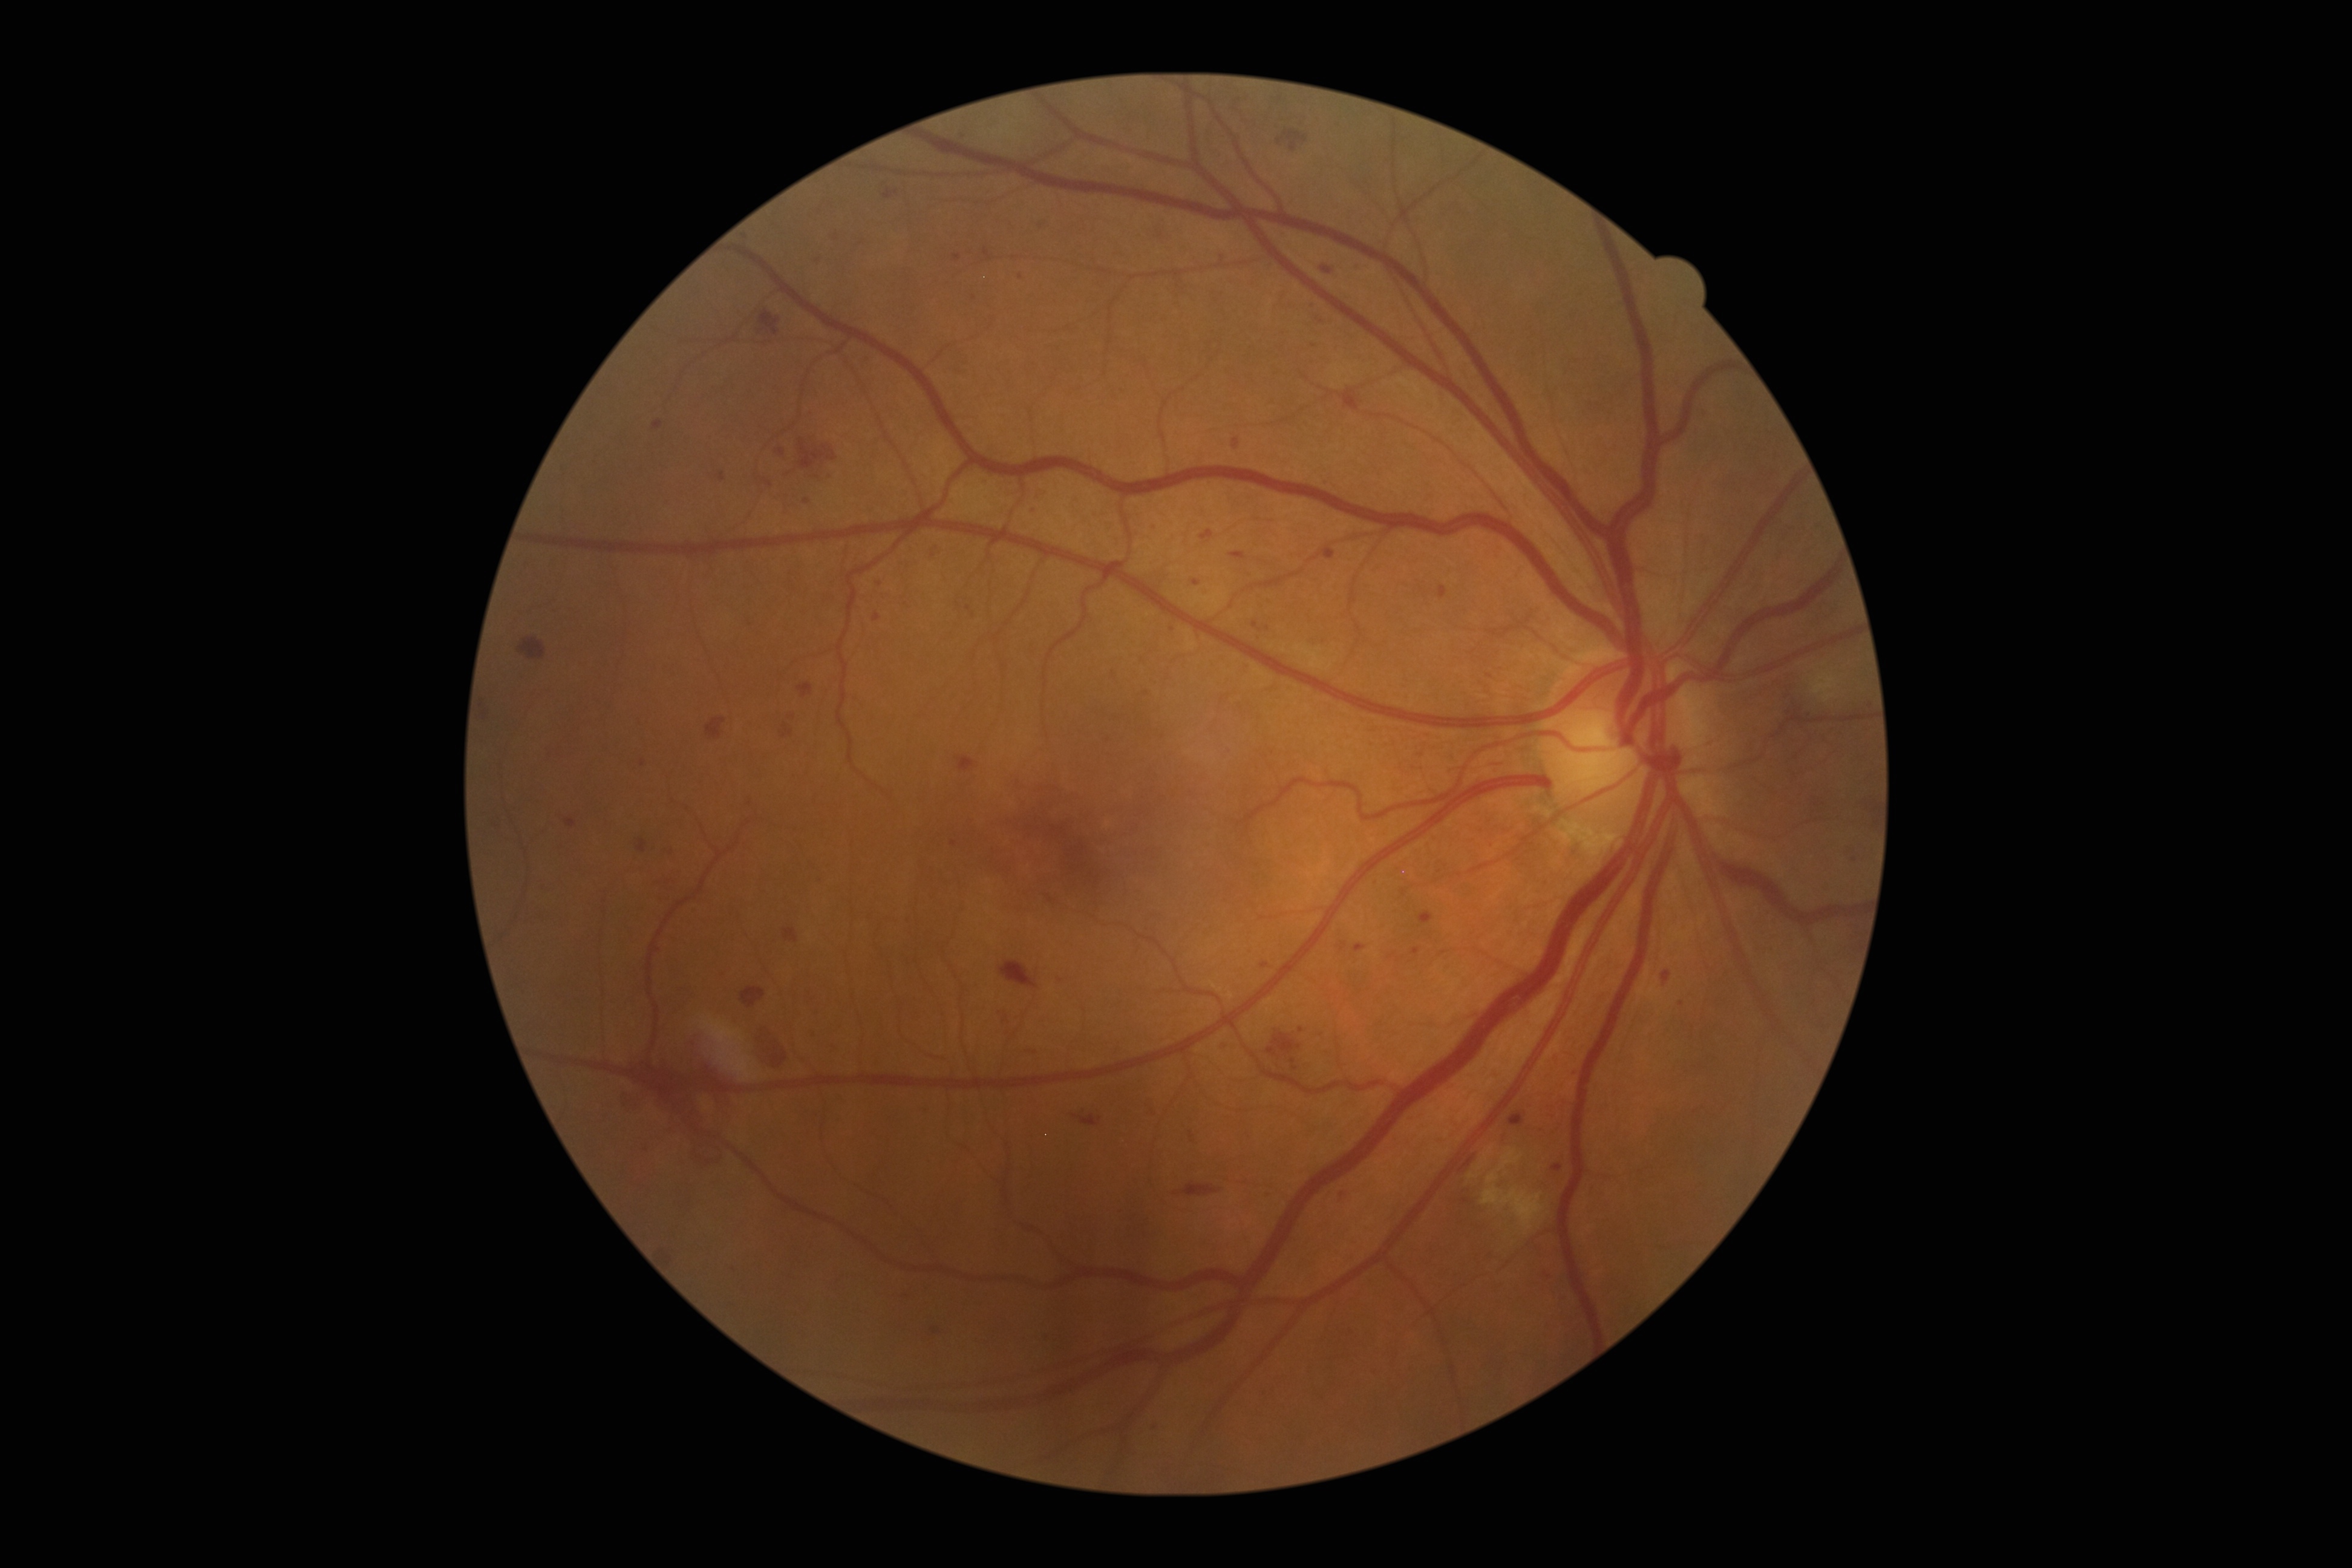
DR: grade 3 — more than 20 intraretinal hemorrhages in each of 4 quadrants, definite venous beading in 2 or more quadrants, or prominent intraretinal microvascular abnormalities in 1 or more quadrants, with no signs of proliferative retinopathy
A subset of detected lesions:
SEs (subset): [left=1329, top=359, right=1353, bottom=389], [left=1811, top=672, right=1842, bottom=702], [left=700, top=1016, right=758, bottom=1082], [left=1481, top=1148, right=1544, bottom=1235]
Additional small SEs near <point>1471, 1175</point>
EXs: none identified
HEs: [left=627, top=1046, right=750, bottom=1131], [left=706, top=718, right=725, bottom=740], [left=620, top=1092, right=633, bottom=1112], [left=518, top=638, right=546, bottom=661], [left=1277, top=130, right=1308, bottom=153], [left=799, top=441, right=838, bottom=470], [left=741, top=987, right=766, bottom=1007], [left=783, top=927, right=798, bottom=943], [left=753, top=1021, right=787, bottom=1071], [left=758, top=312, right=780, bottom=336], [left=1000, top=961, right=1037, bottom=988], [left=1184, top=1183, right=1220, bottom=1196], [left=688, top=1137, right=724, bottom=1172], [left=1266, top=1033, right=1301, bottom=1056], [left=655, top=1247, right=675, bottom=1270], [left=1073, top=1114, right=1102, bottom=1126], [left=479, top=695, right=493, bottom=718]
MAs (subset): [left=1149, top=1109, right=1155, bottom=1119], [left=764, top=480, right=774, bottom=488], [left=1459, top=1155, right=1475, bottom=1173], [left=1662, top=971, right=1671, bottom=983], [left=654, top=422, right=664, bottom=431], [left=1221, top=1042, right=1230, bottom=1051], [left=777, top=449, right=785, bottom=456], [left=1041, top=215, right=1054, bottom=228], [left=637, top=839, right=648, bottom=852]
Additional small MAs near <point>1302, 1030</point>, <point>1790, 712</point>, <point>1107, 738</point>, <point>1032, 512</point>, <point>1344, 946</point>, <point>1060, 980</point>, <point>833, 477</point>, <point>819, 477</point>, <point>1473, 651</point>